NIDEK AFC-230:
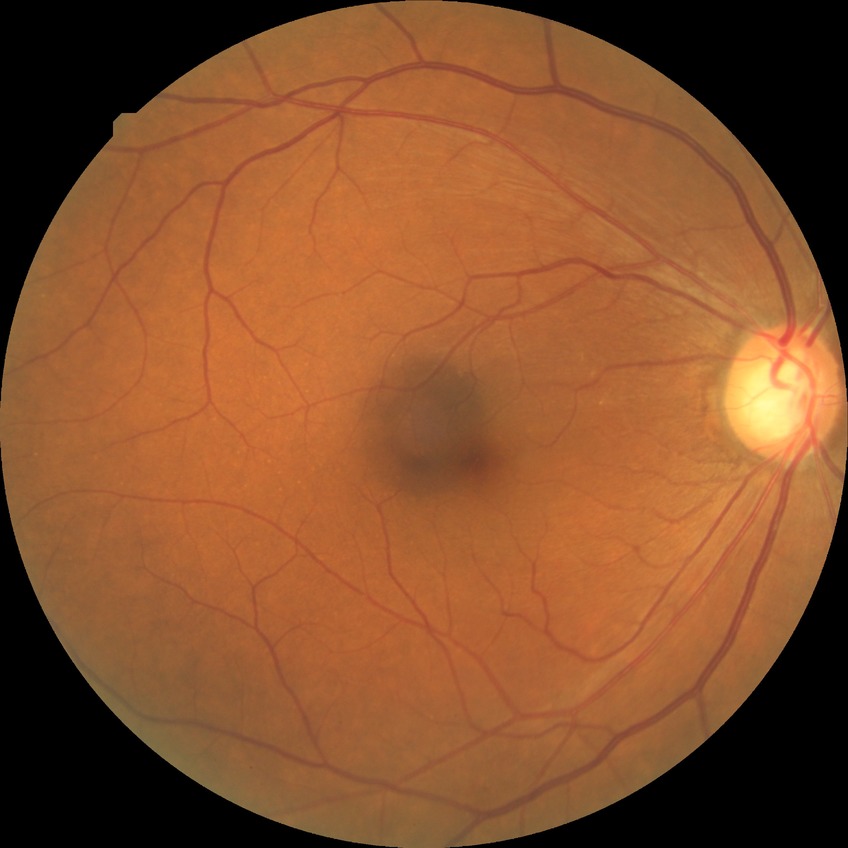 Retinopathy grade: no diabetic retinopathy.